Wide-field contact fundus photograph of an infant: 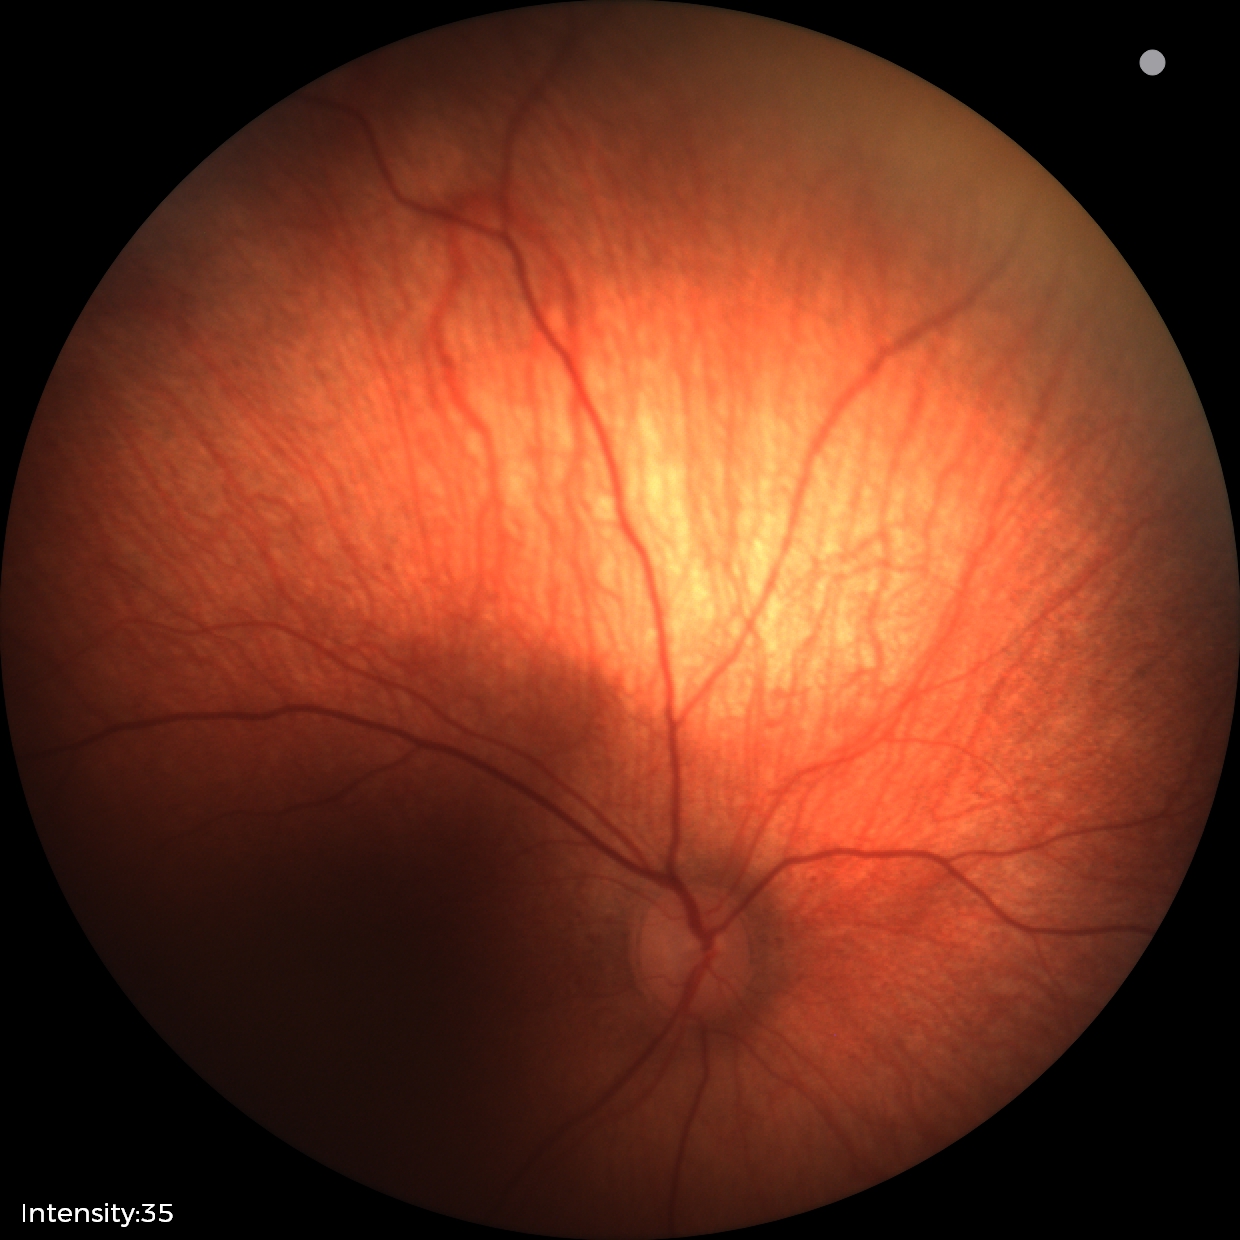

Screening examination diagnosed as physiological.